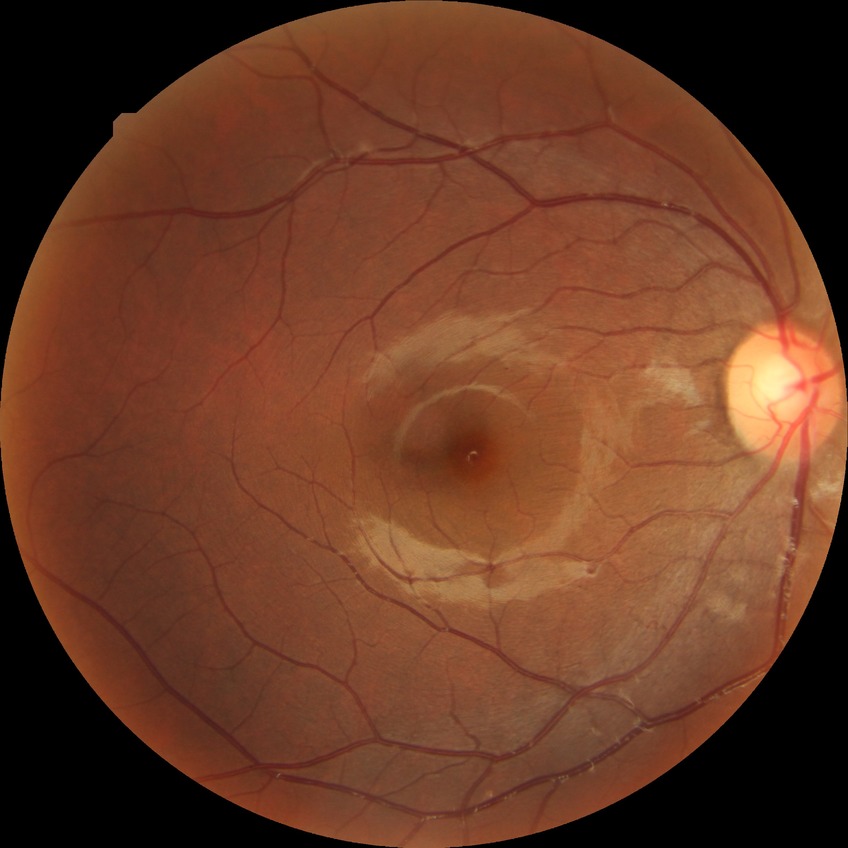 diabetic retinopathy (DR): NDR (no diabetic retinopathy).